Phoenix ICON wide-field infant fundus image:
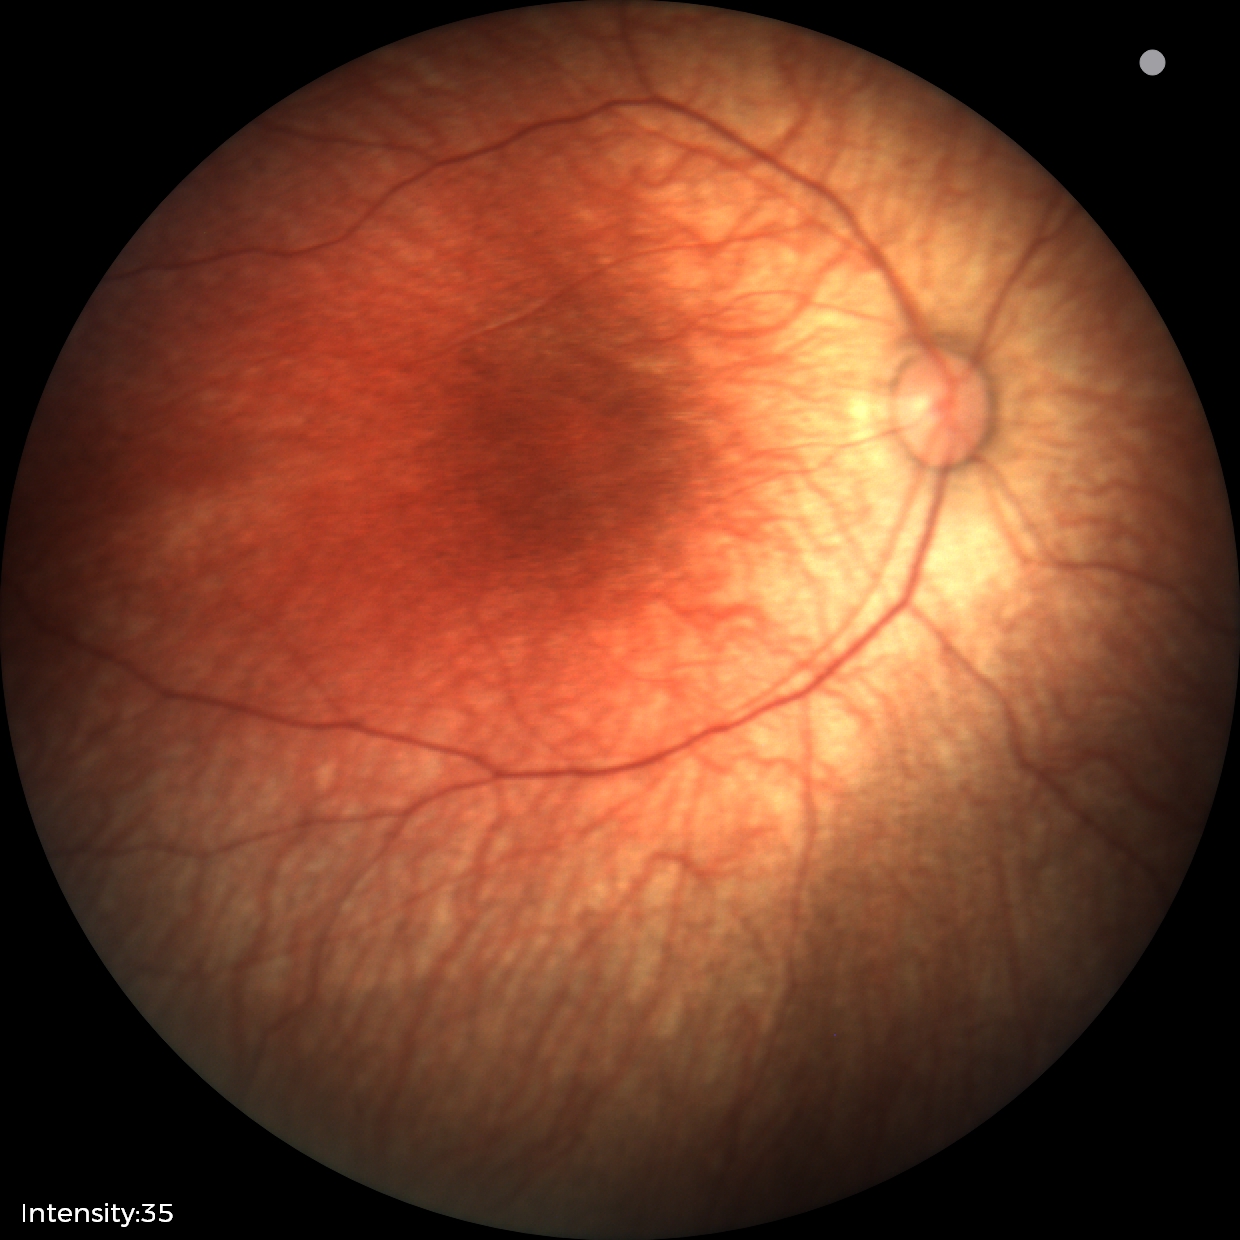

Screening examination diagnosed as physiological.